Diabetic retinopathy graded by the modified Davis classification, without pupil dilation, 848x848:
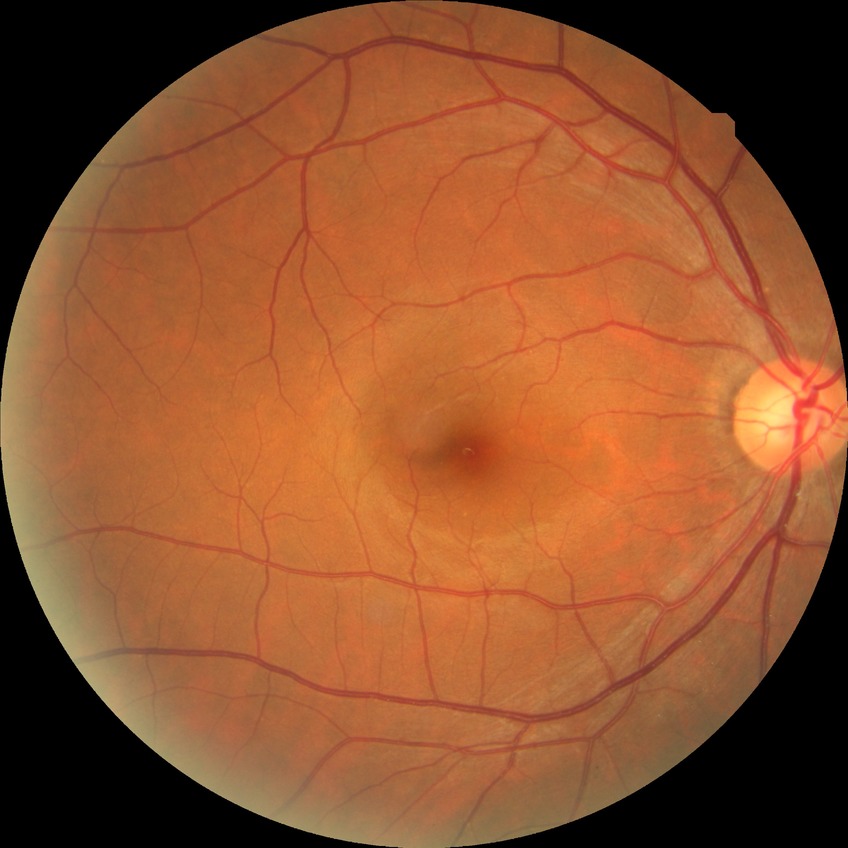 modified Davis grade = NDR, DR impression = negative for DR.